Wide-field contact fundus photograph of an infant. 640x480px:
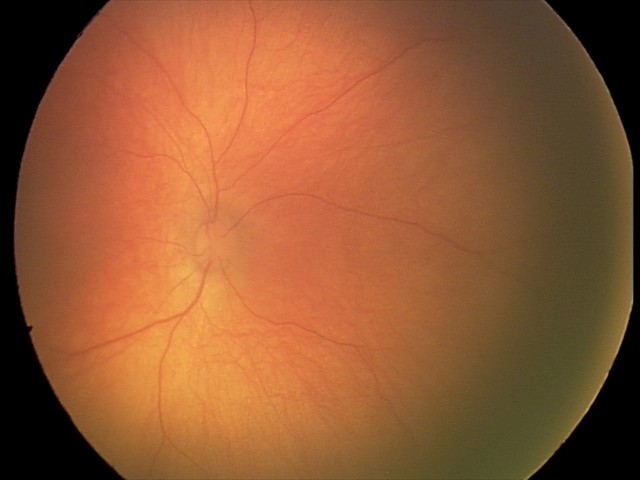
Normal screening examination.